Posterior pole color fundus photograph. 45-degree field of view. Without pupil dilation:
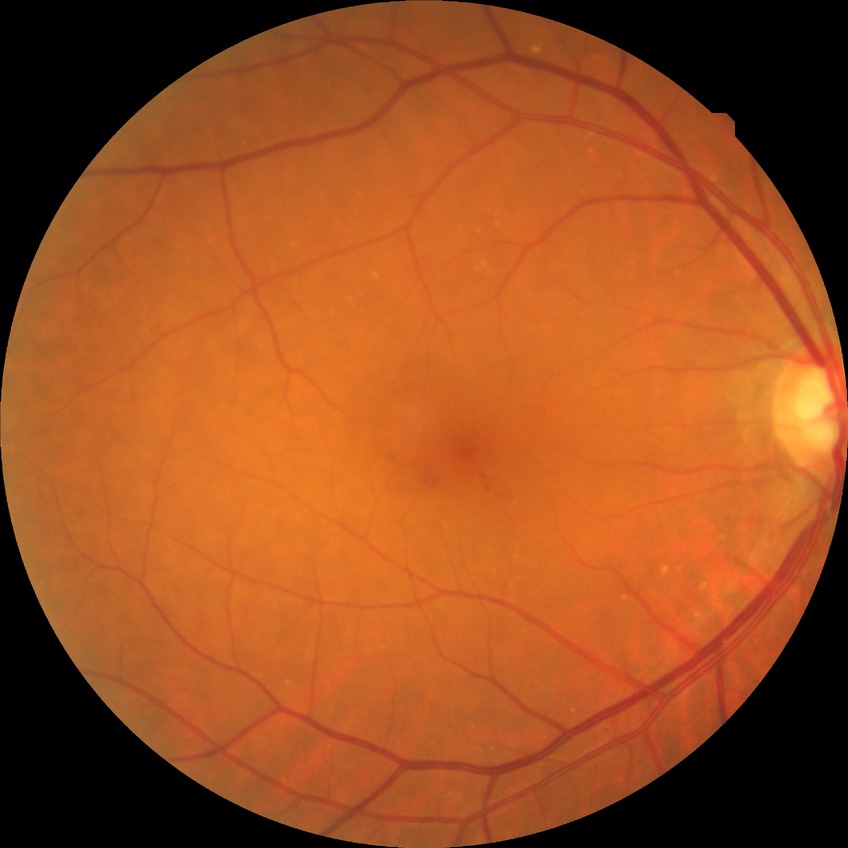 DR grade = SDR.